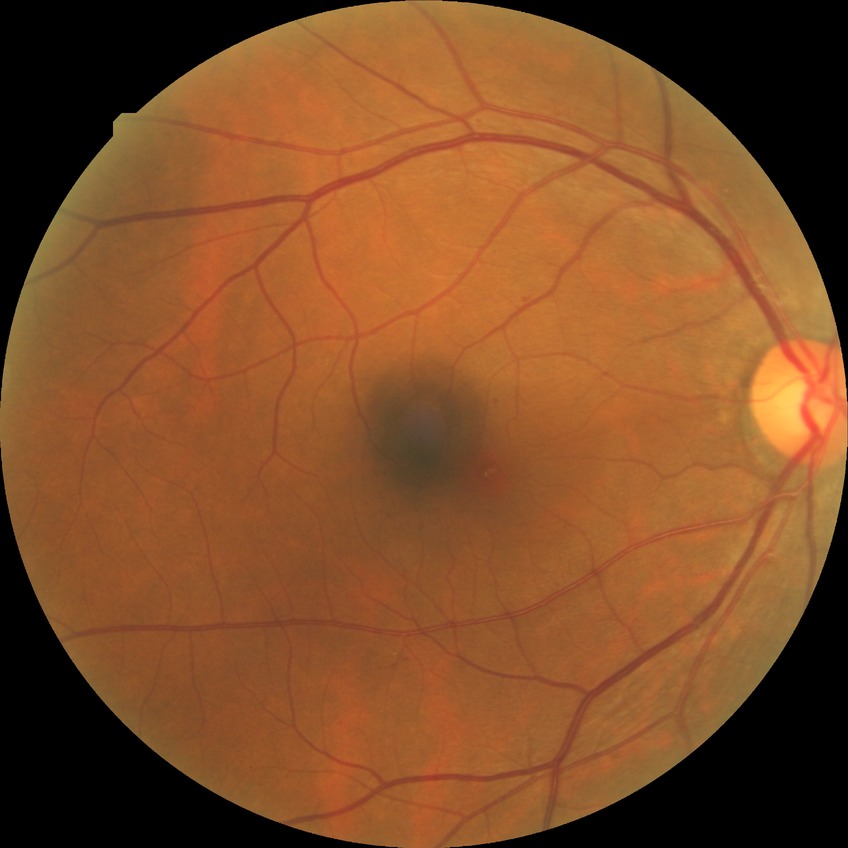 DR severity is SDR.